DR severity per modified Davis staging: 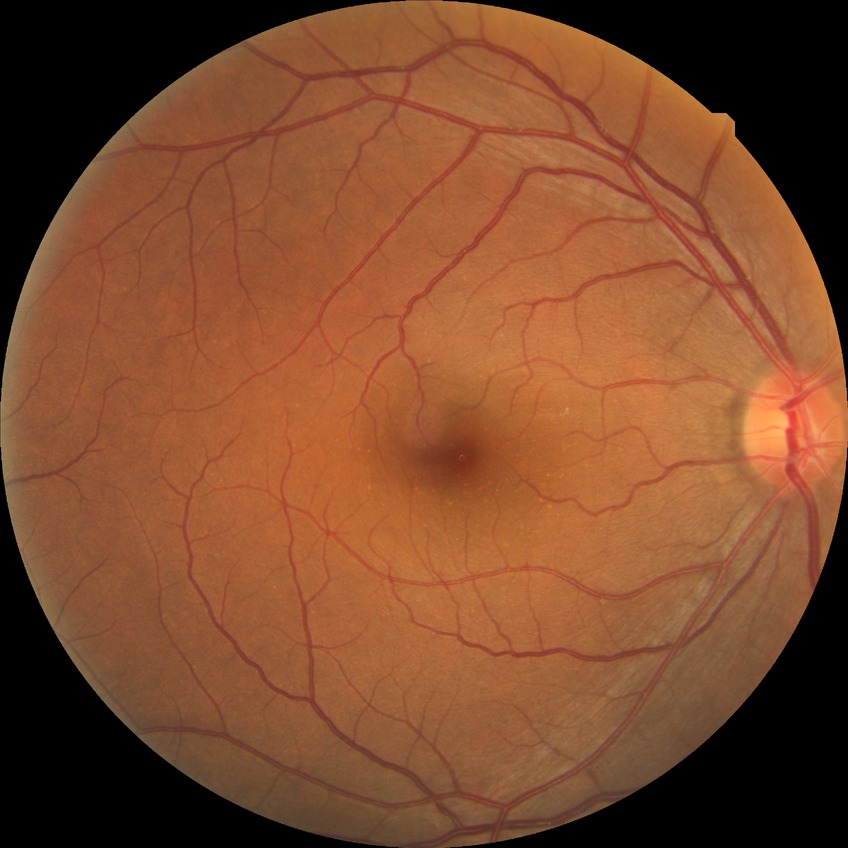

davis_grade: no diabetic retinopathy (NDR)